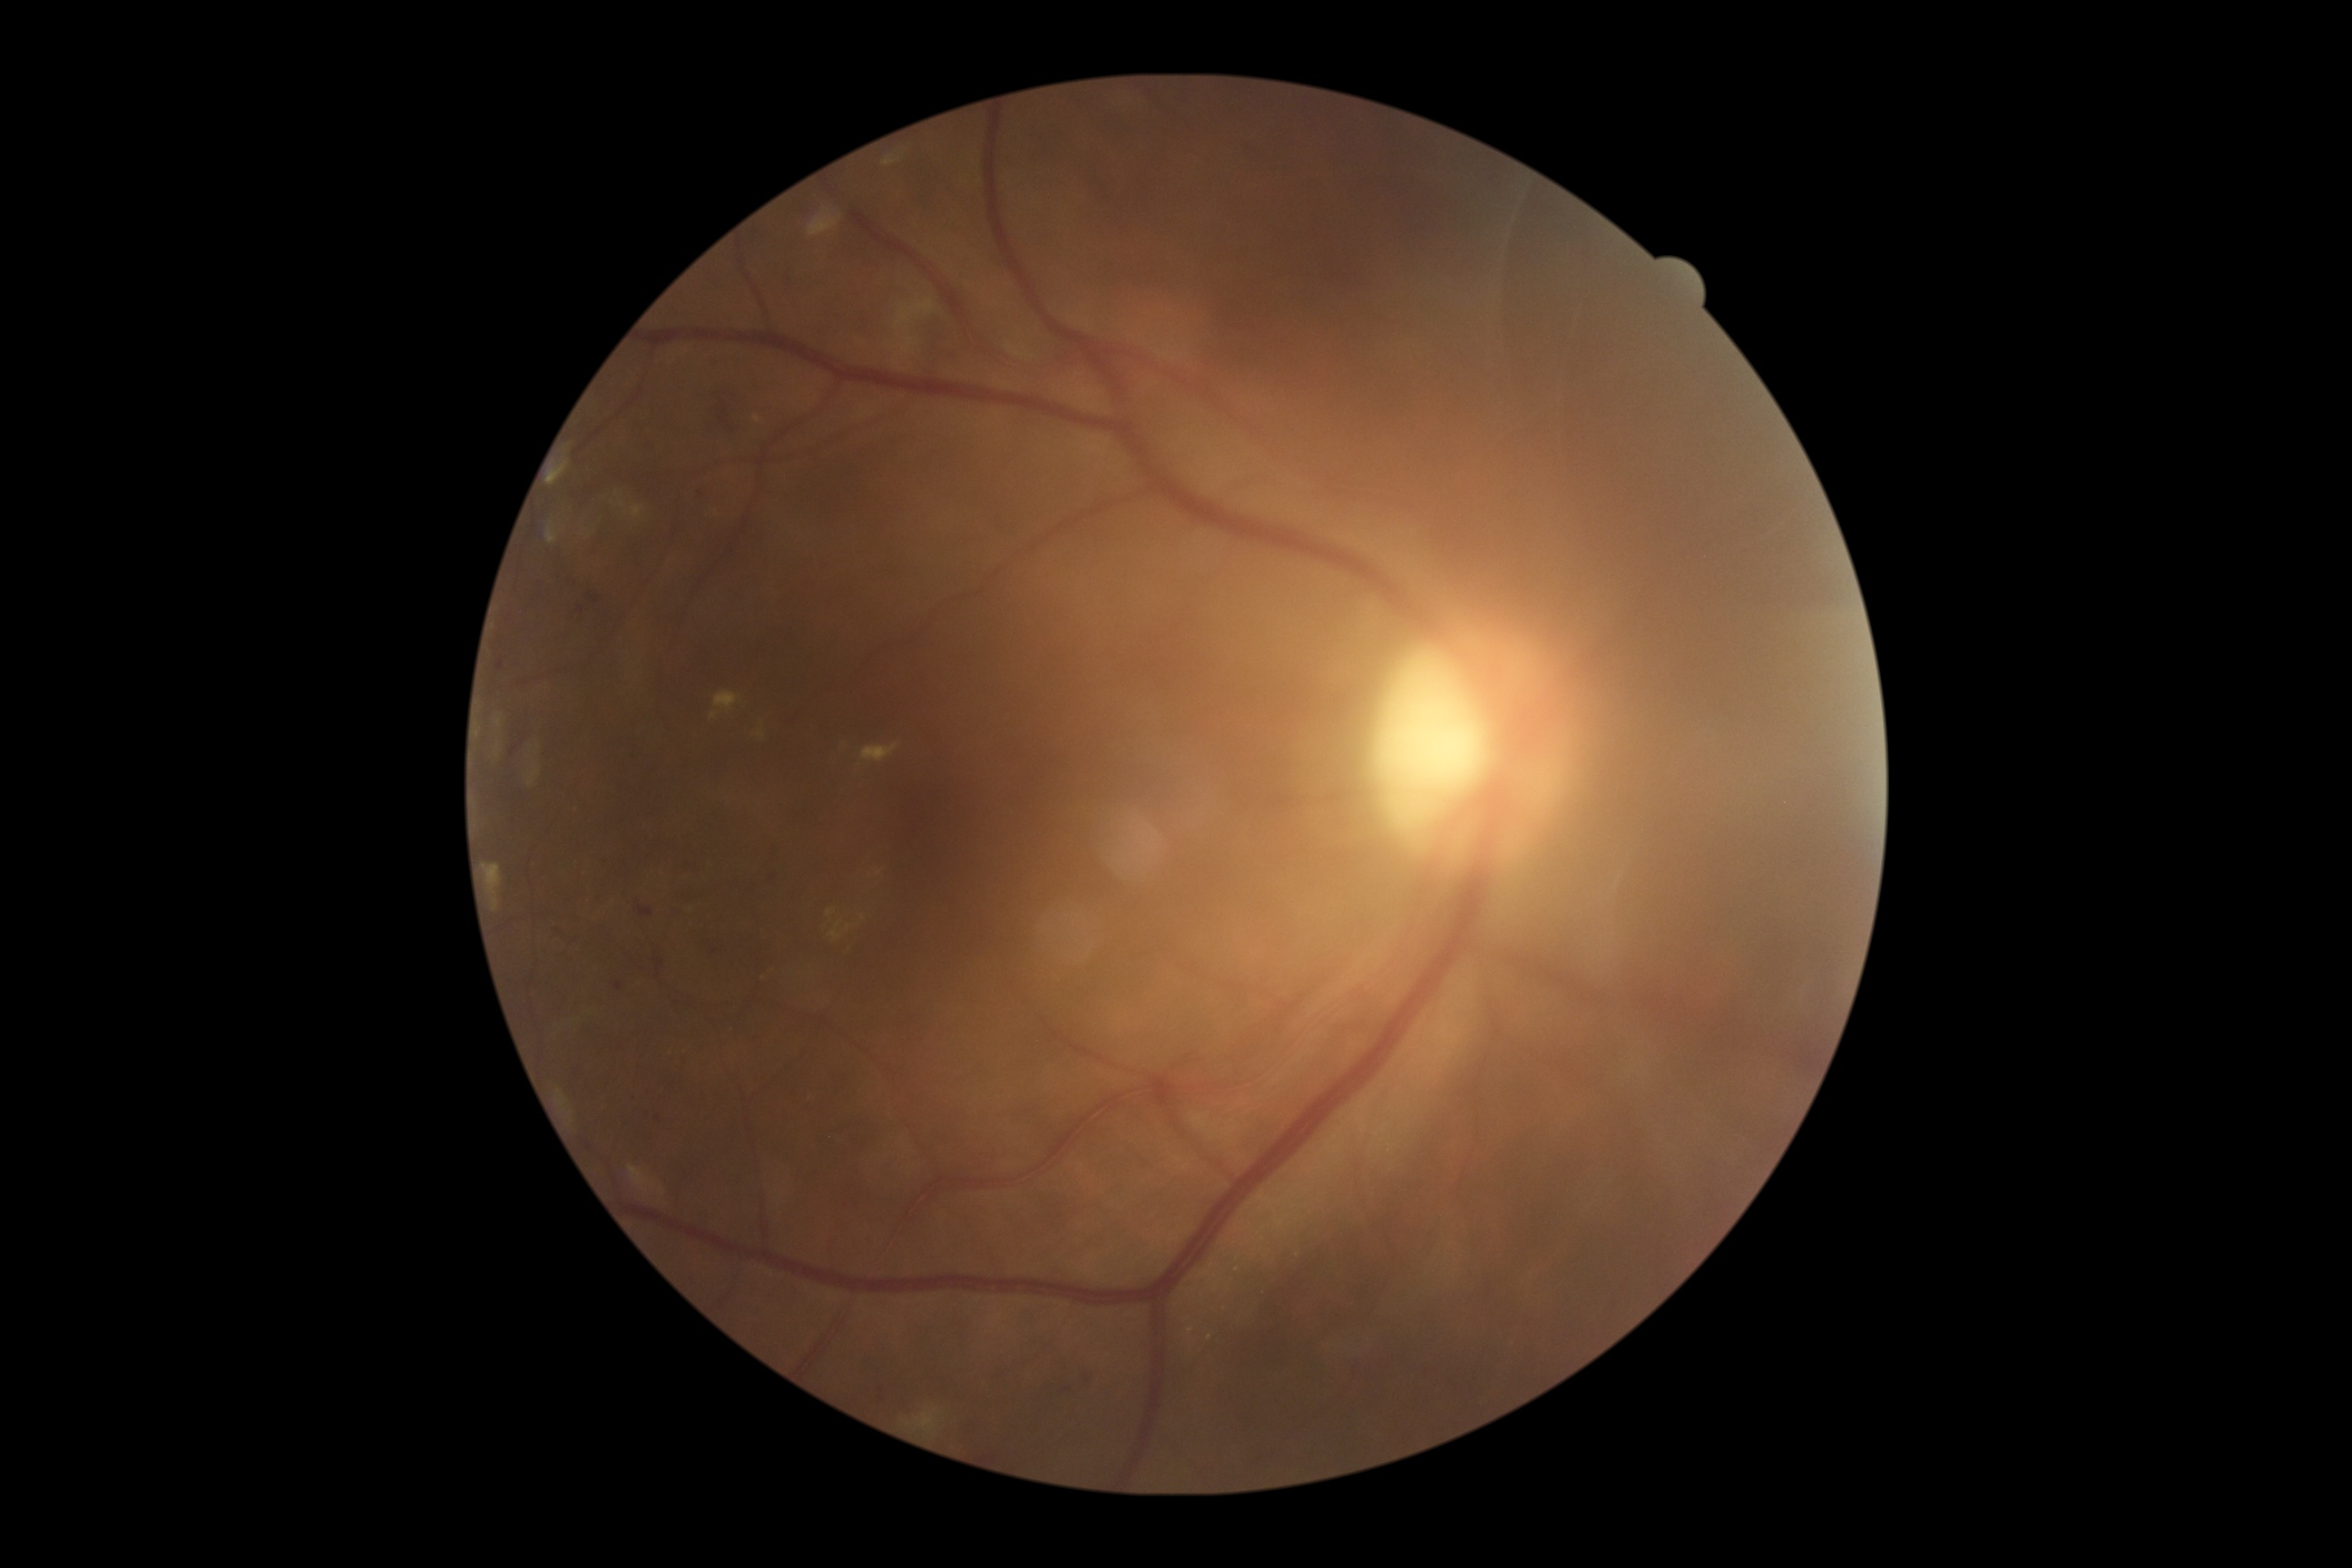

– diabetic retinopathy grade — moderate NPDR (2) — more than just microaneurysms but less than severe NPDR